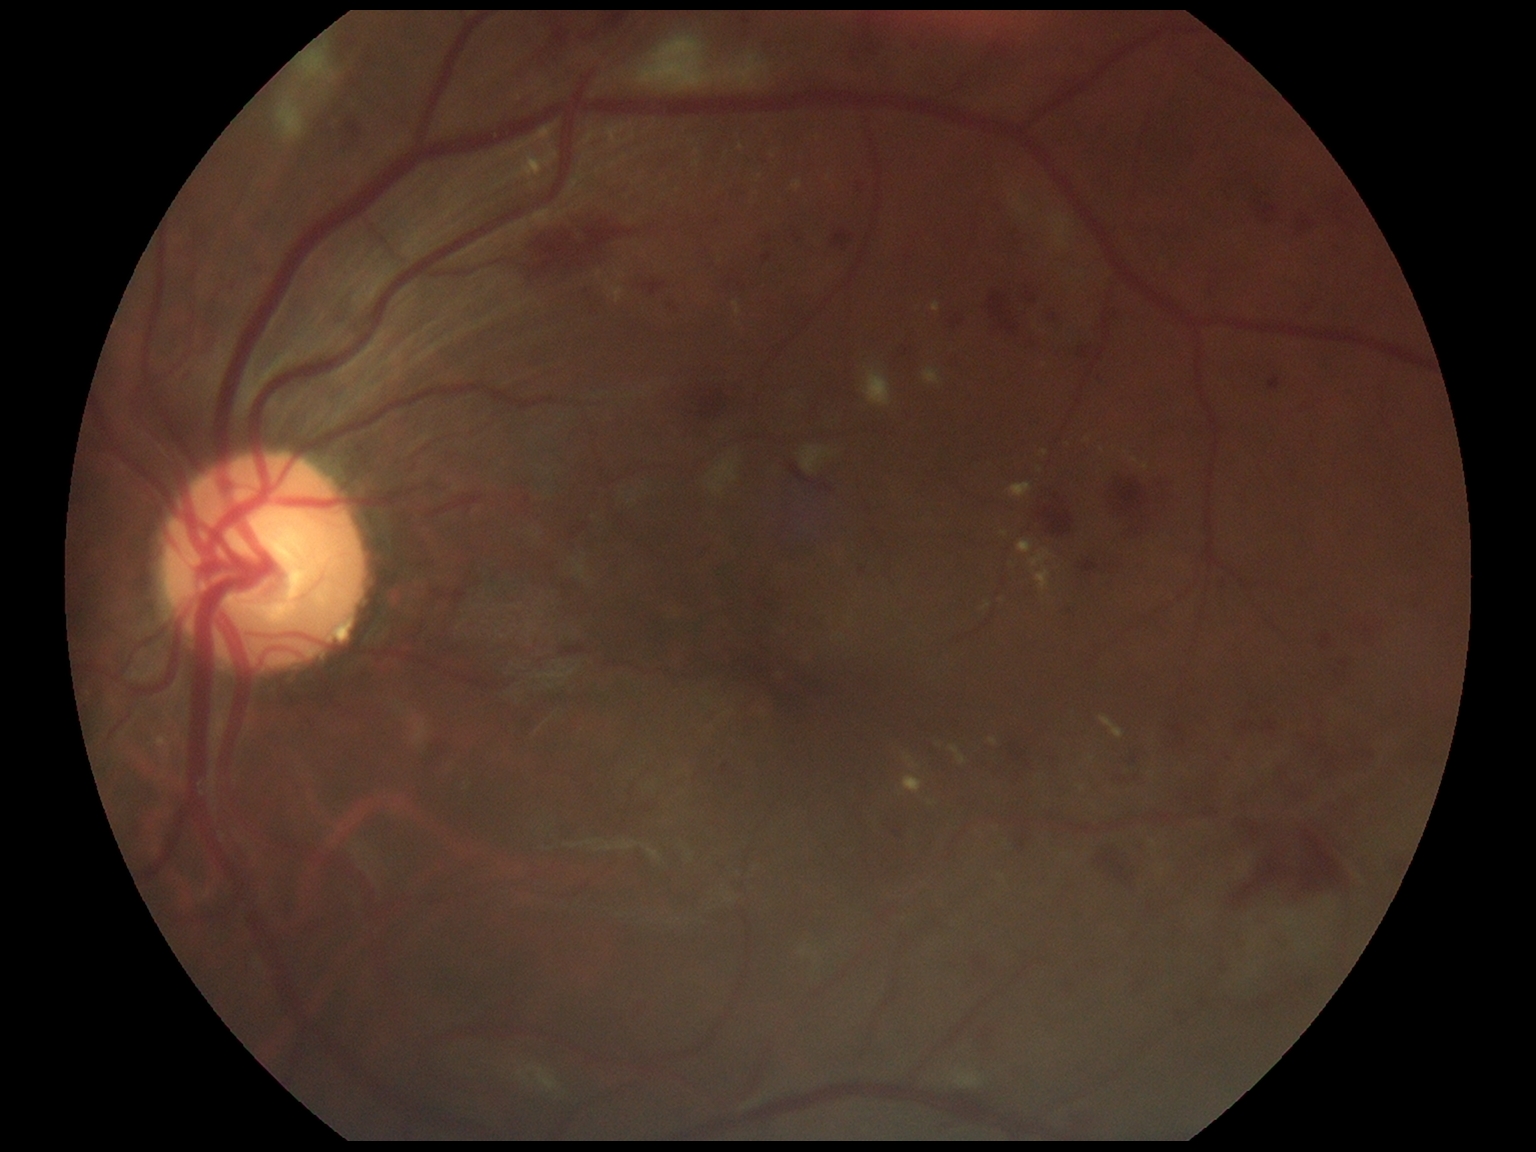 DR grade: severe non-proliferative diabetic retinopathy (3).